Nonmydriatic fundus photograph, FOV: 45 degrees, NIDEK AFC-230 fundus camera, 848 x 848 pixels, color fundus image: 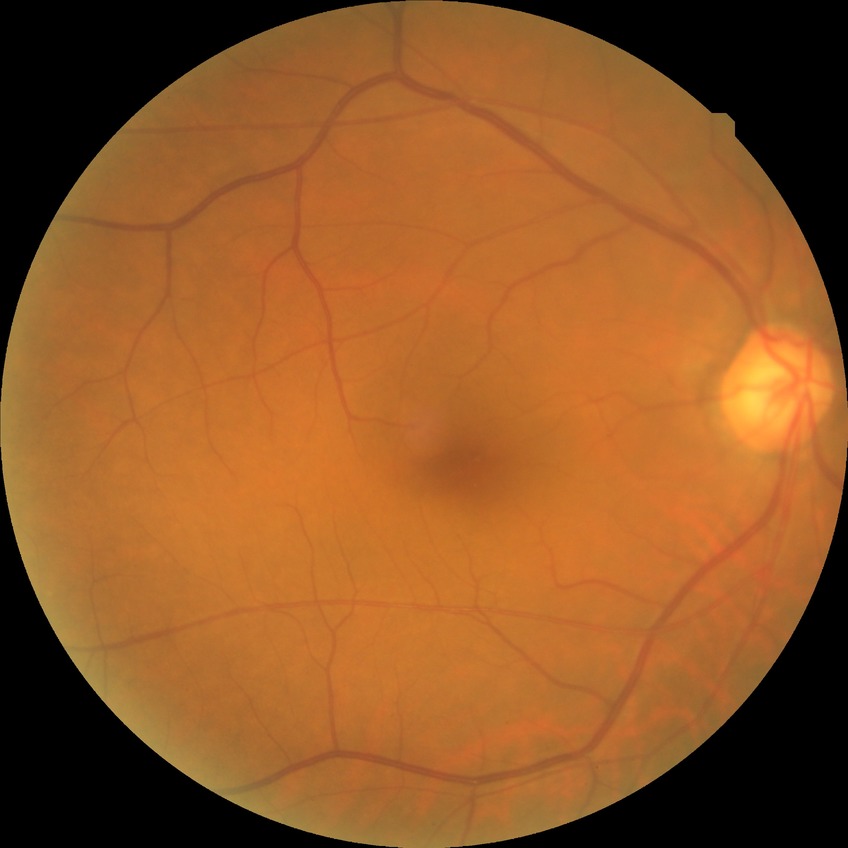

Diabetic retinopathy (DR): NDR (no diabetic retinopathy).